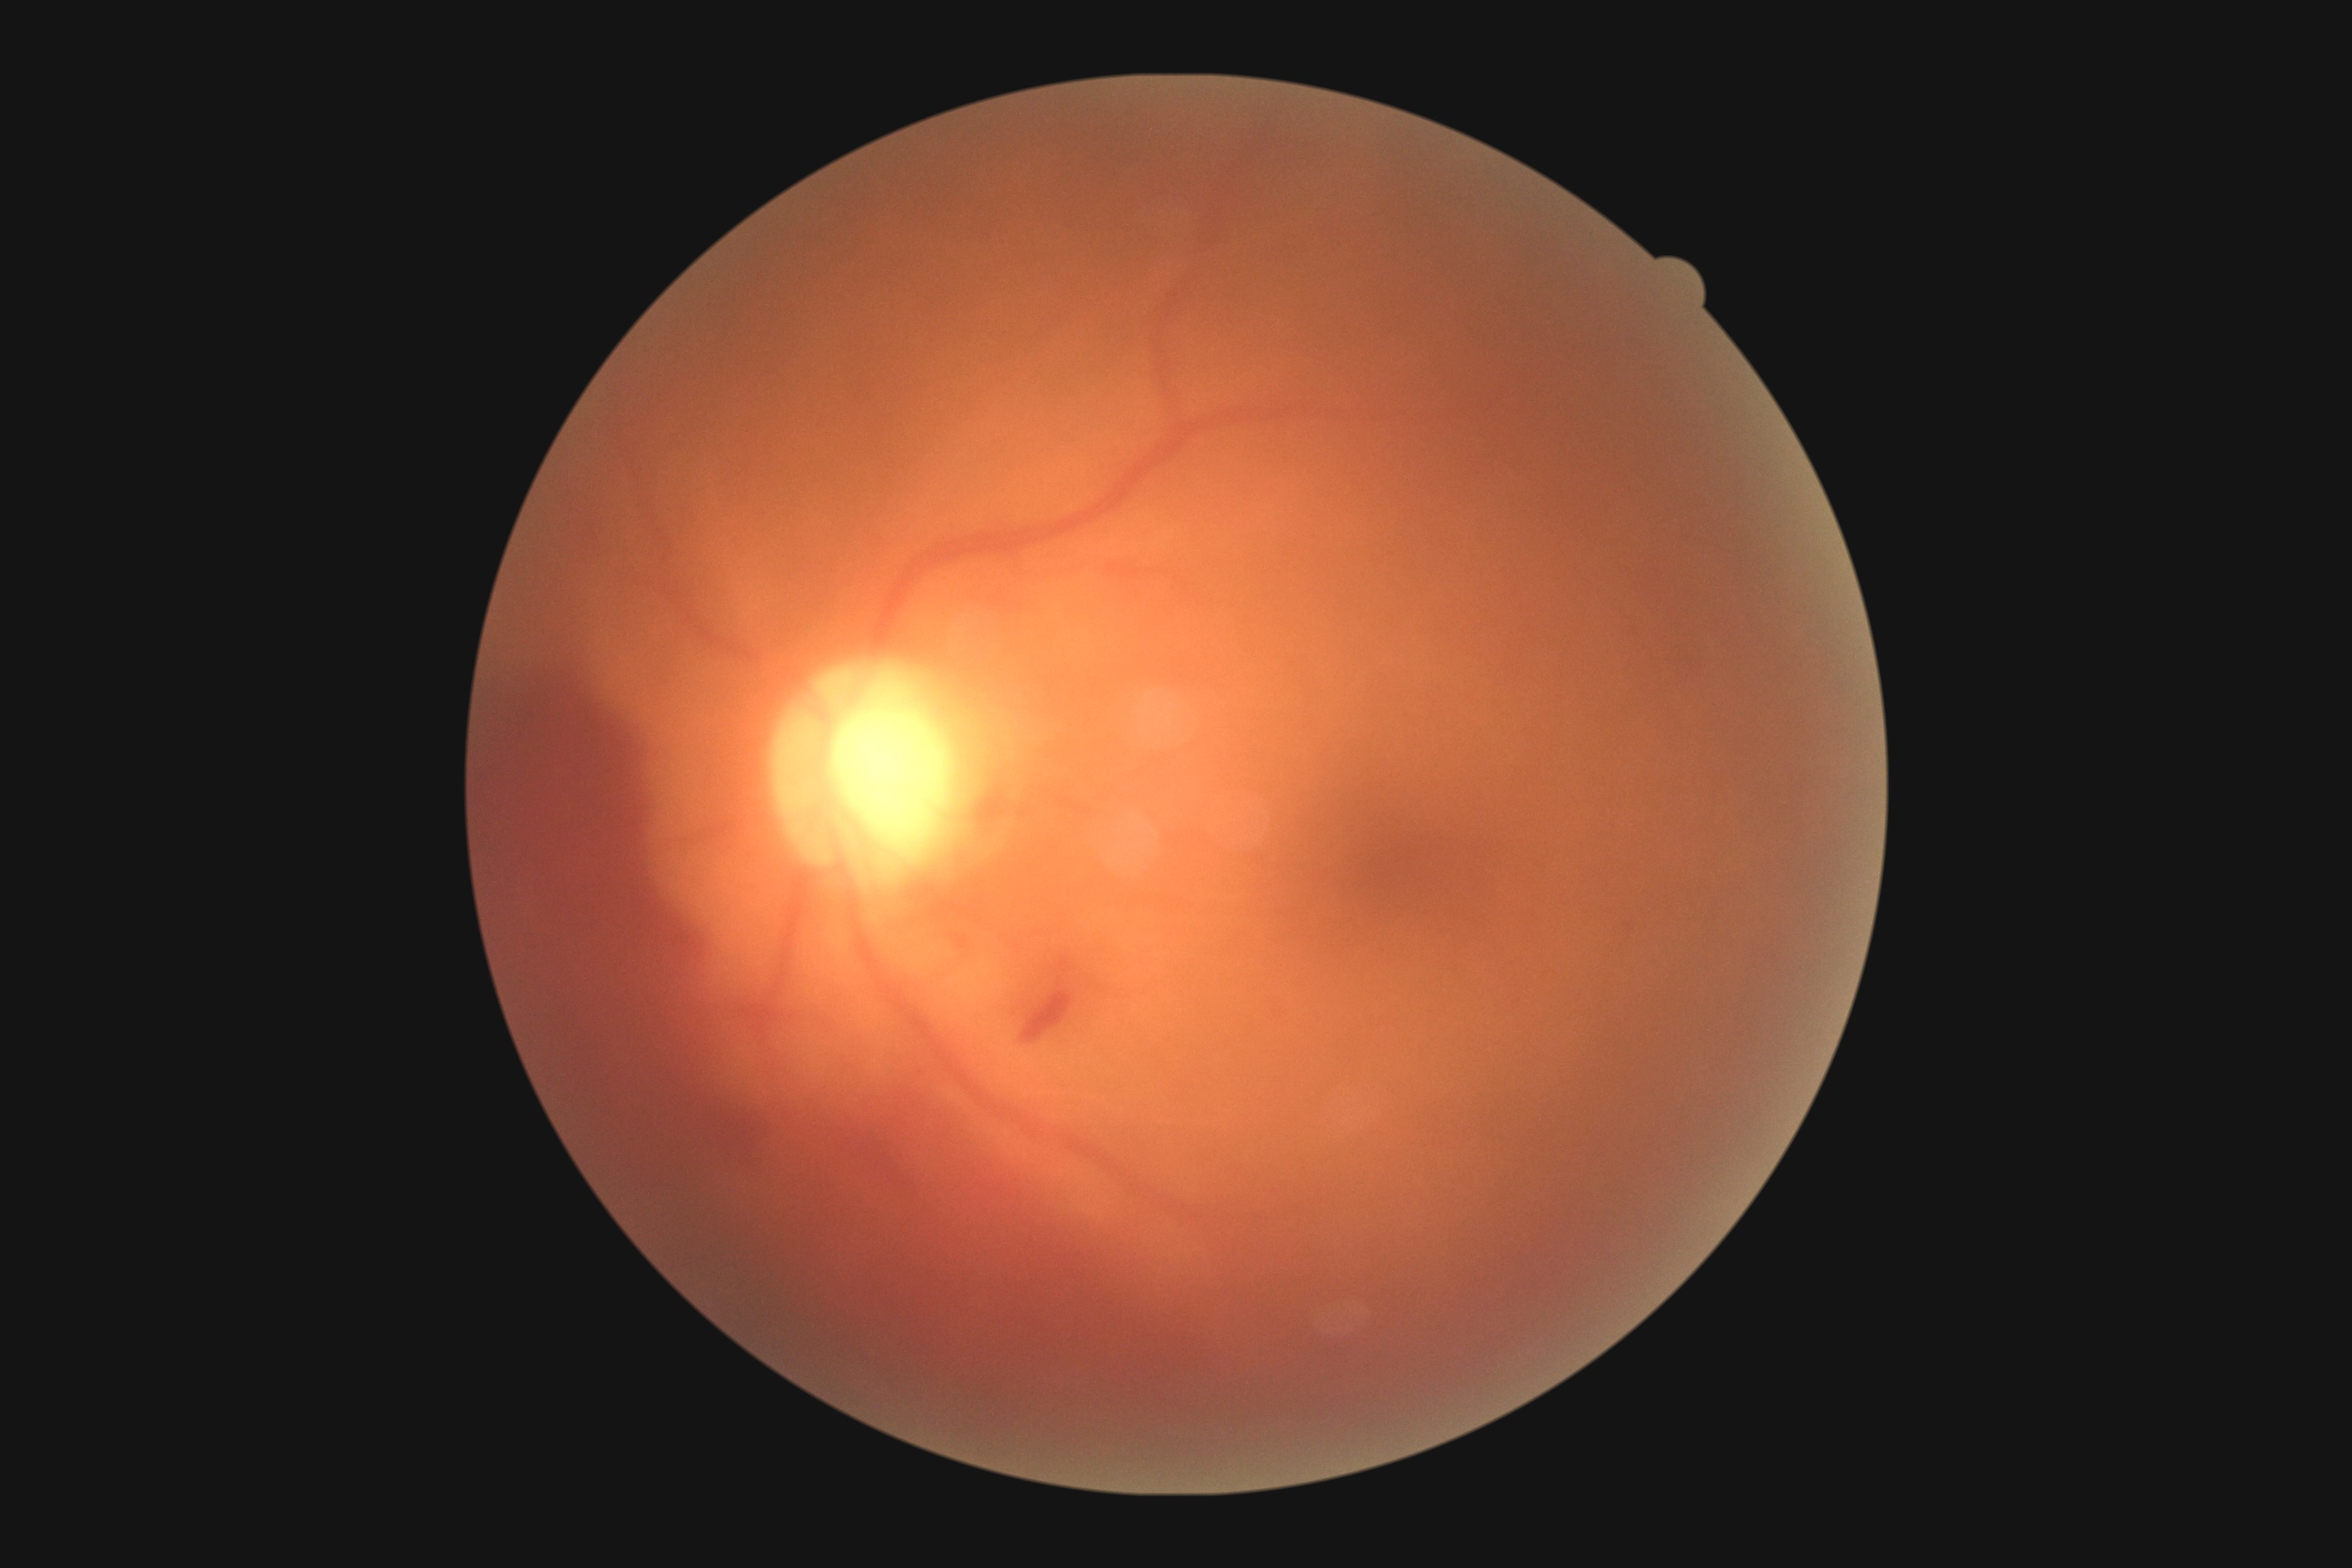
DR stage: PDR (grade 4).